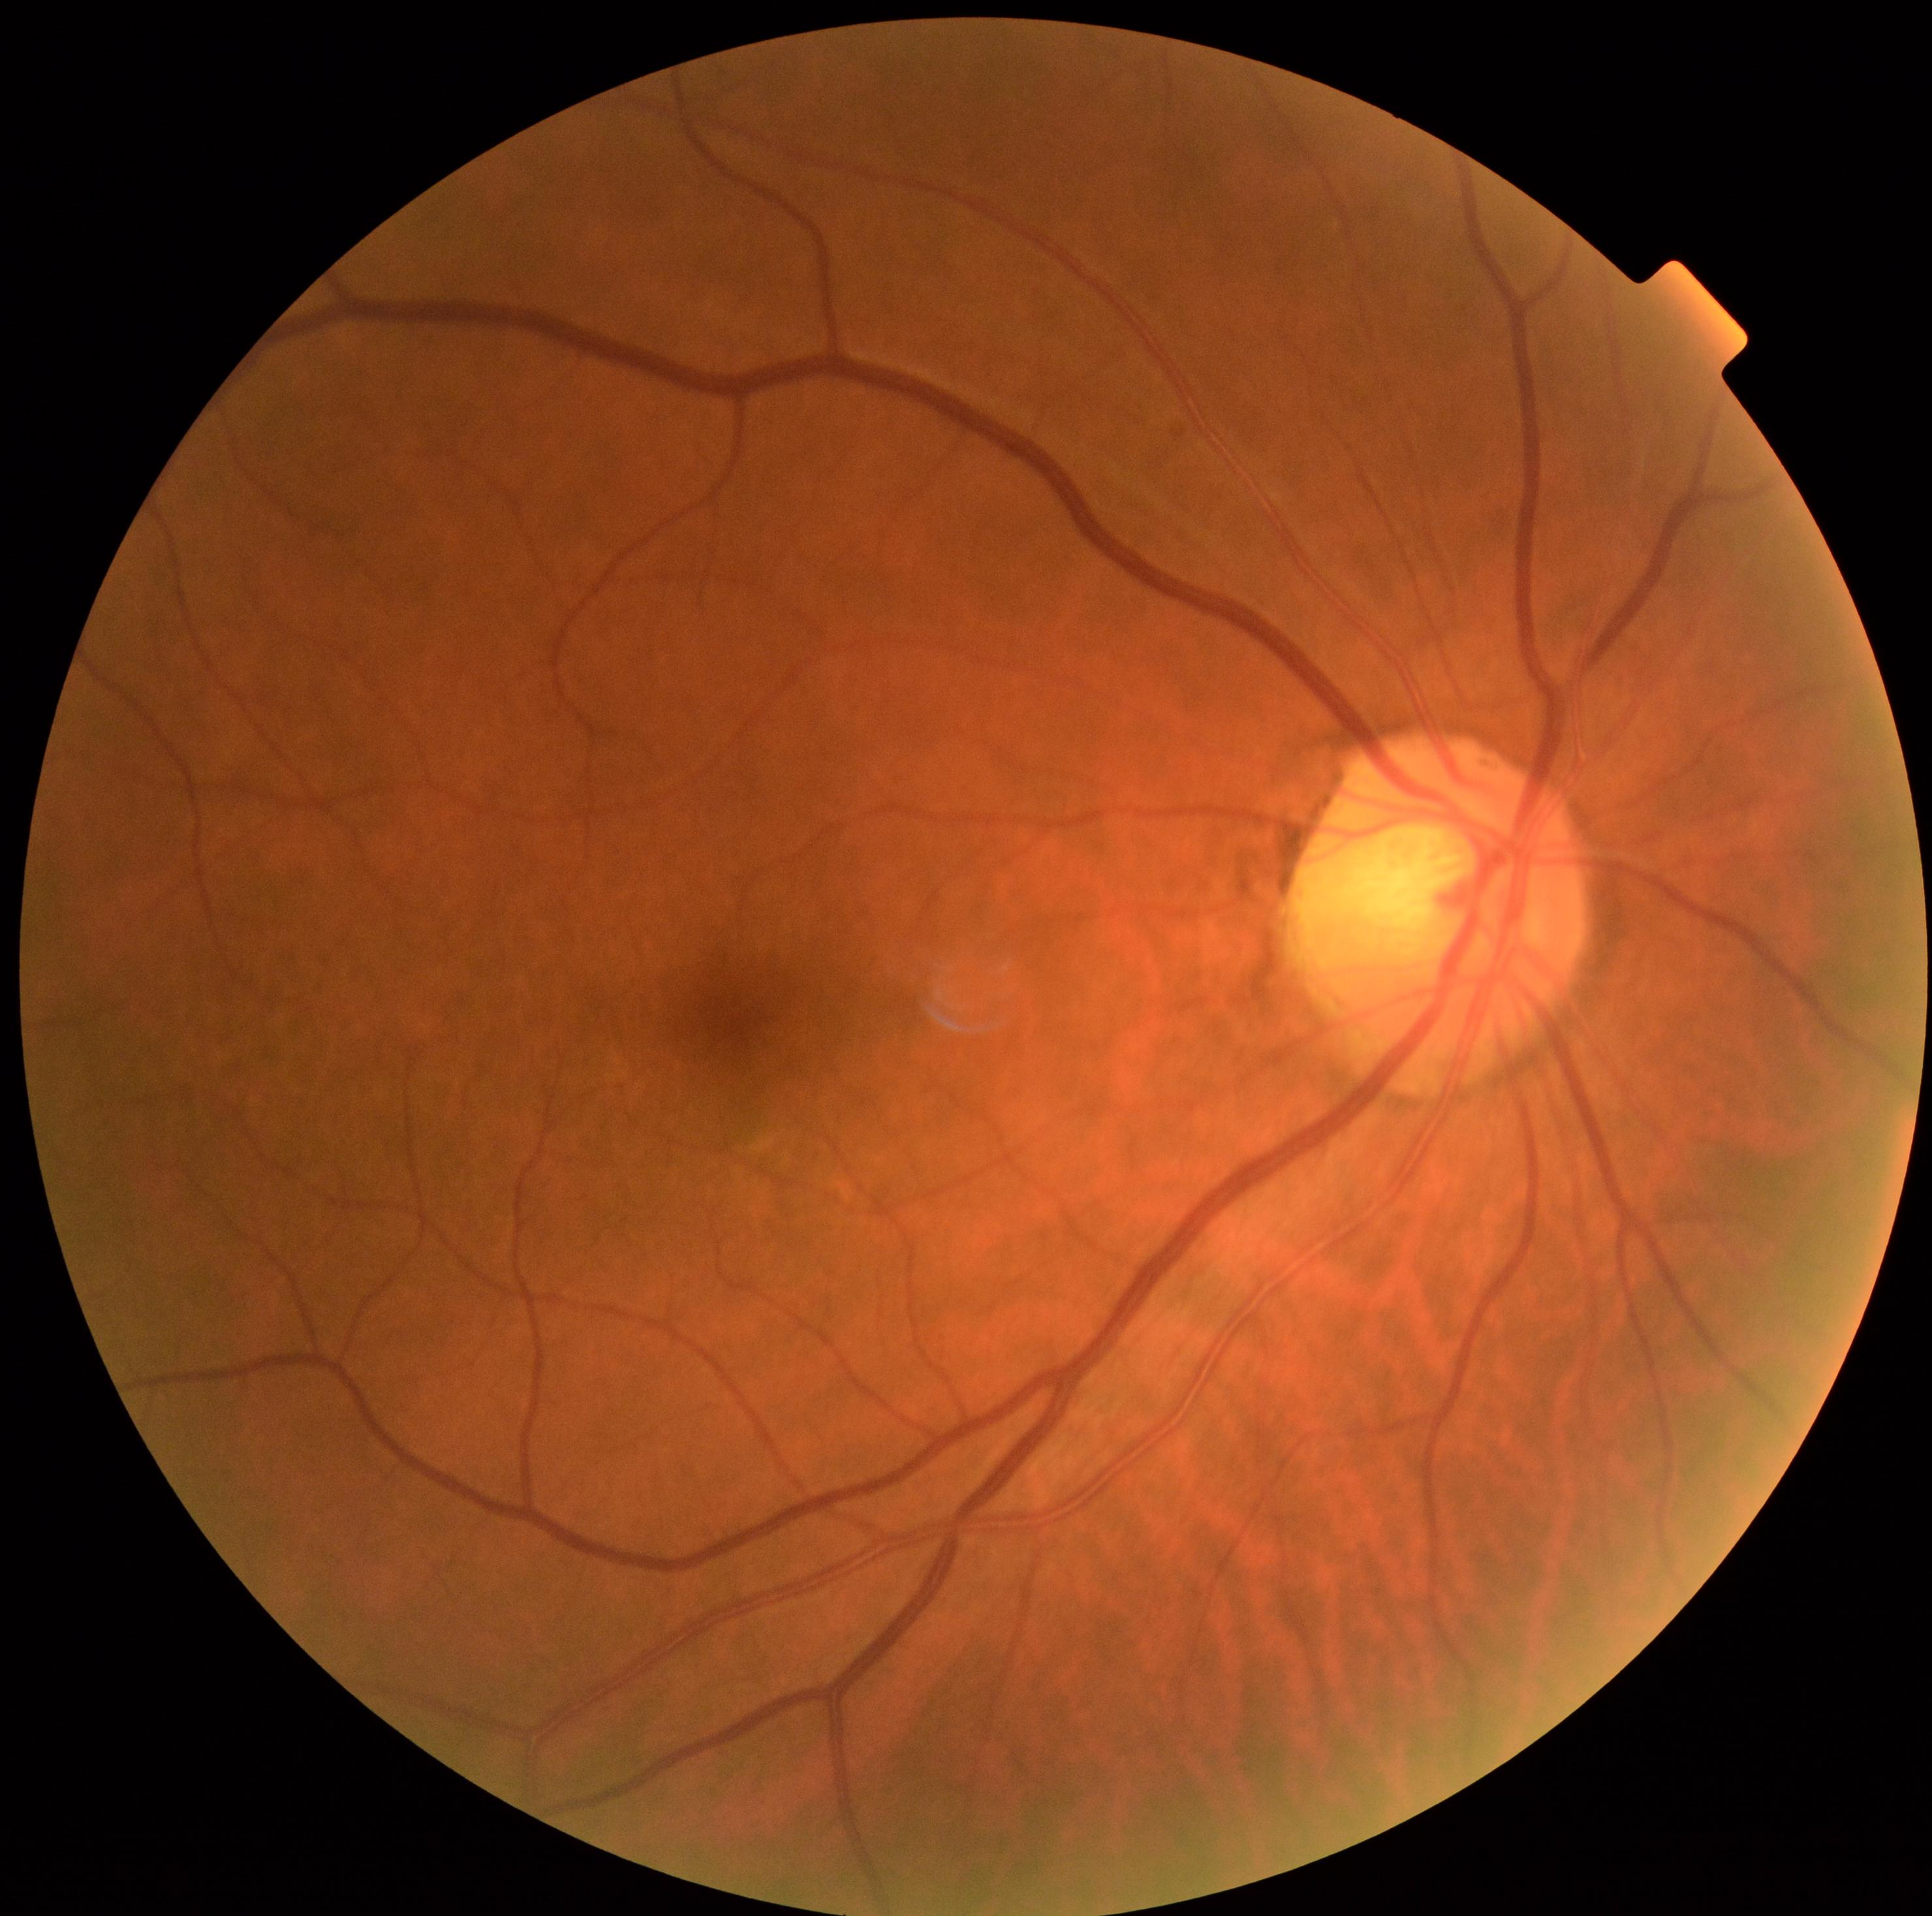

diabetic retinopathy grade@0 (no apparent retinopathy).